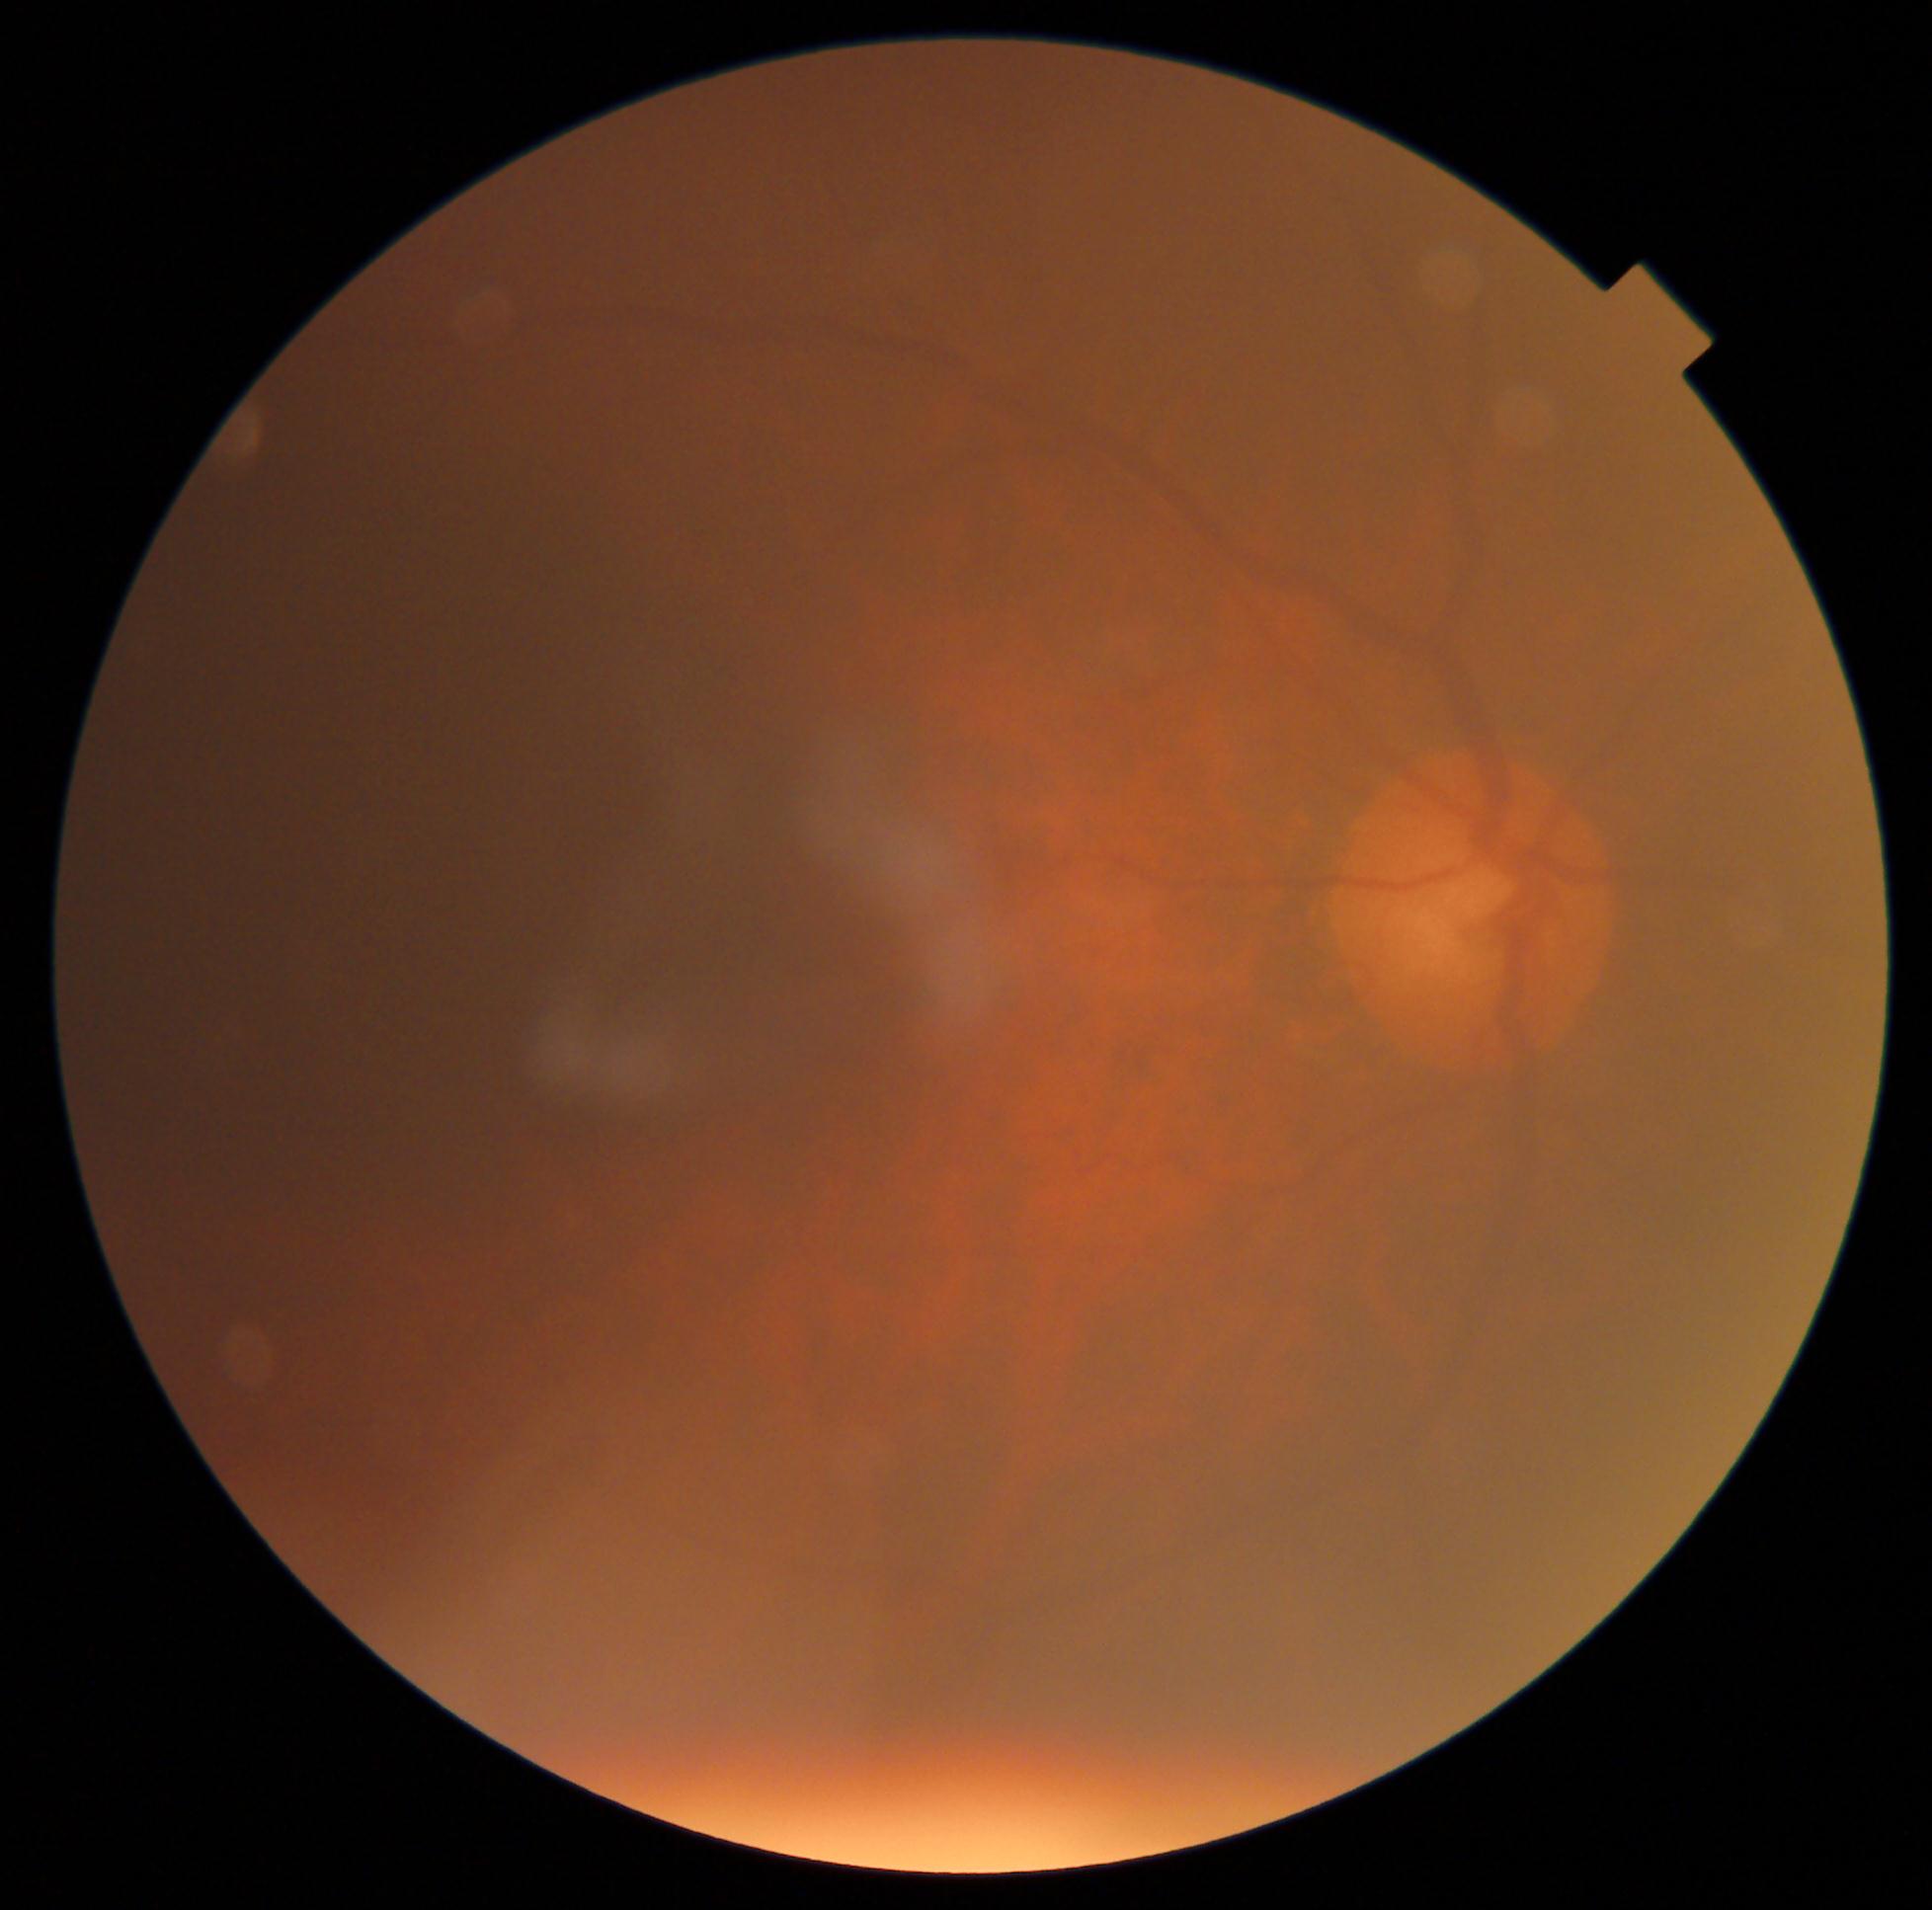

{
  "dr_grade": "0/4 — no visible signs of diabetic retinopathy"
}